Wide-field fundus image from infant ROP screening
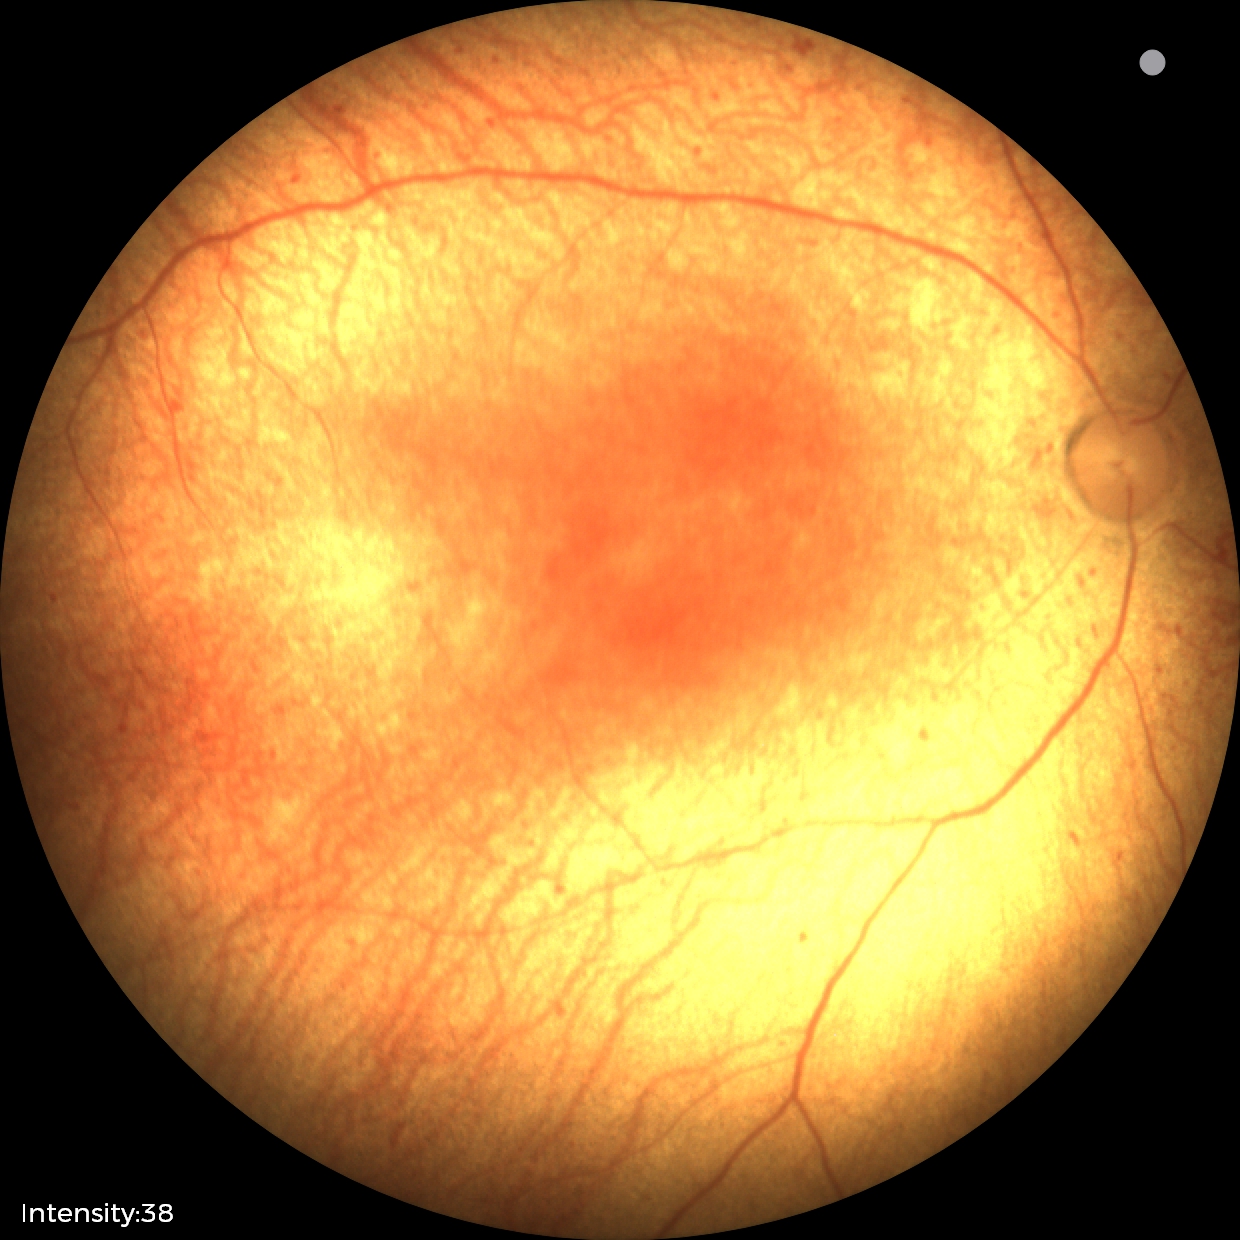

Without plus disease.
Examination diagnosed as status post retinopathy of prematurity (ROP) — retinal appearance after treated retinopathy of prematurity.